Diabetic retinopathy graded by the modified Davis classification, NIDEK AFC-230 fundus camera.
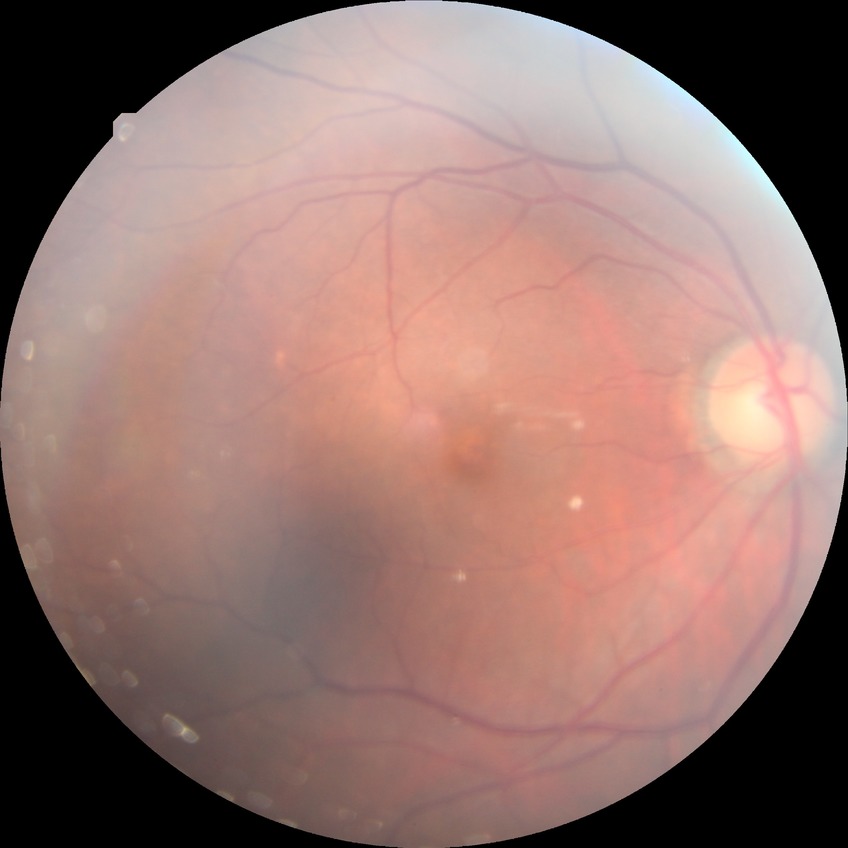 Modified Davis classification is no diabetic retinopathy.